45° FOV · CFP:
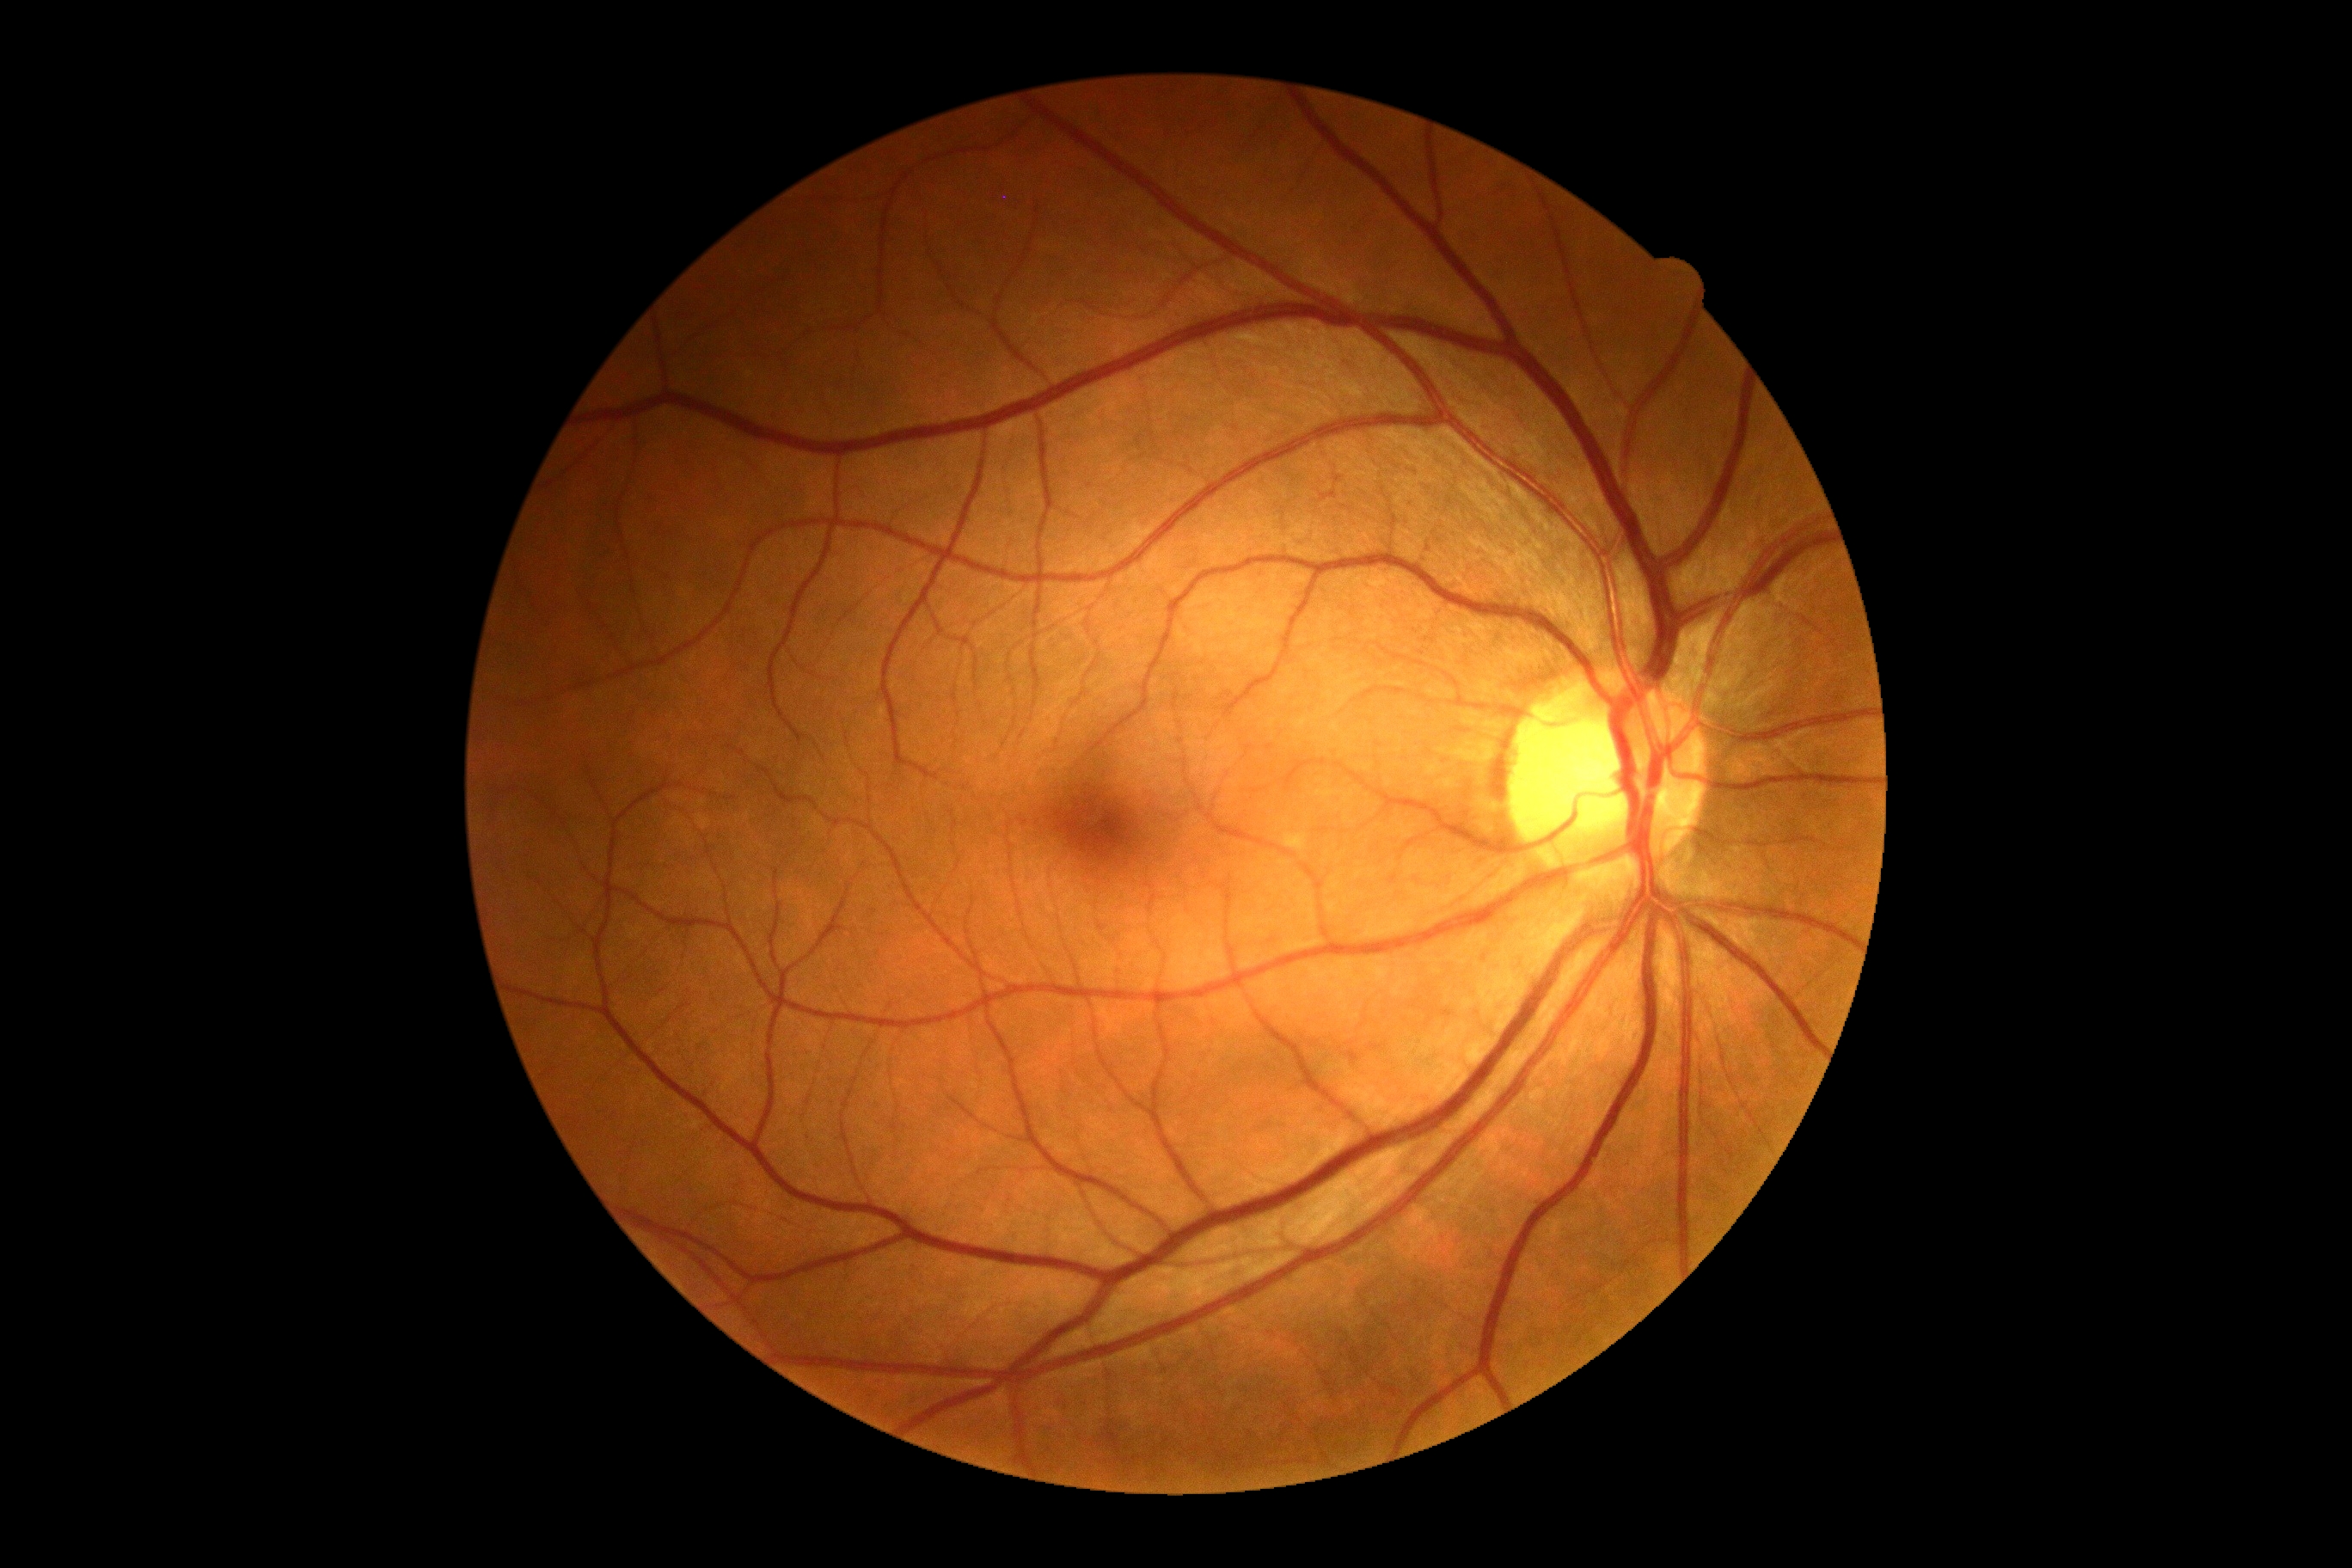

Diabetic retinopathy grade is 0 (no apparent retinopathy).